DR severity per modified Davis staging; no pharmacologic dilation; 848x848px:
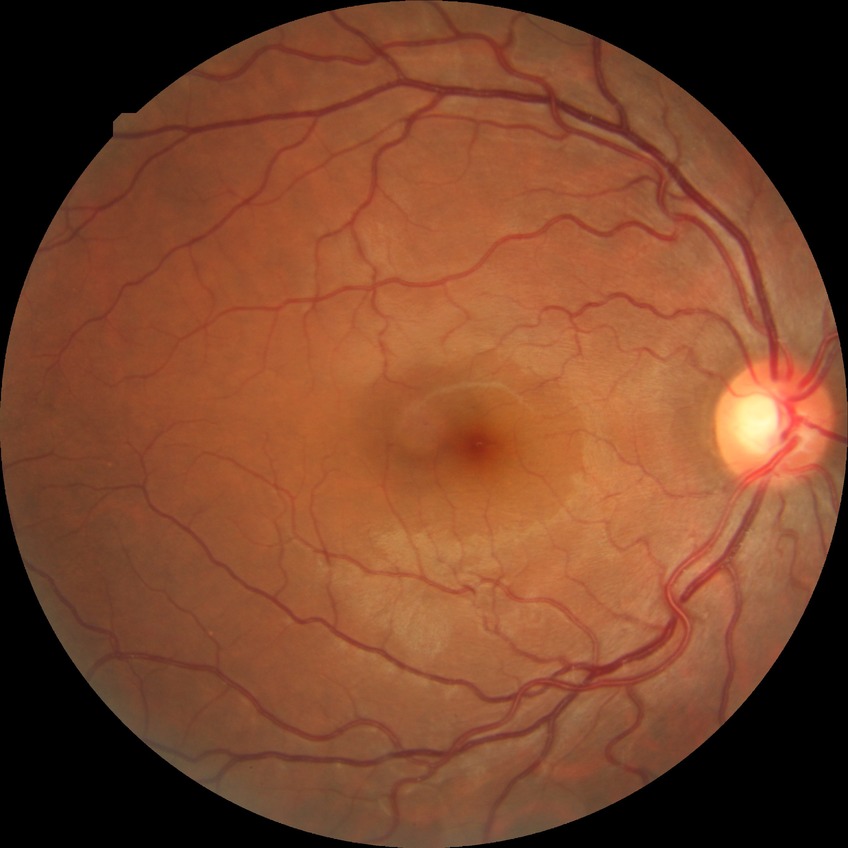 diabetic retinopathy grade: no diabetic retinopathy.